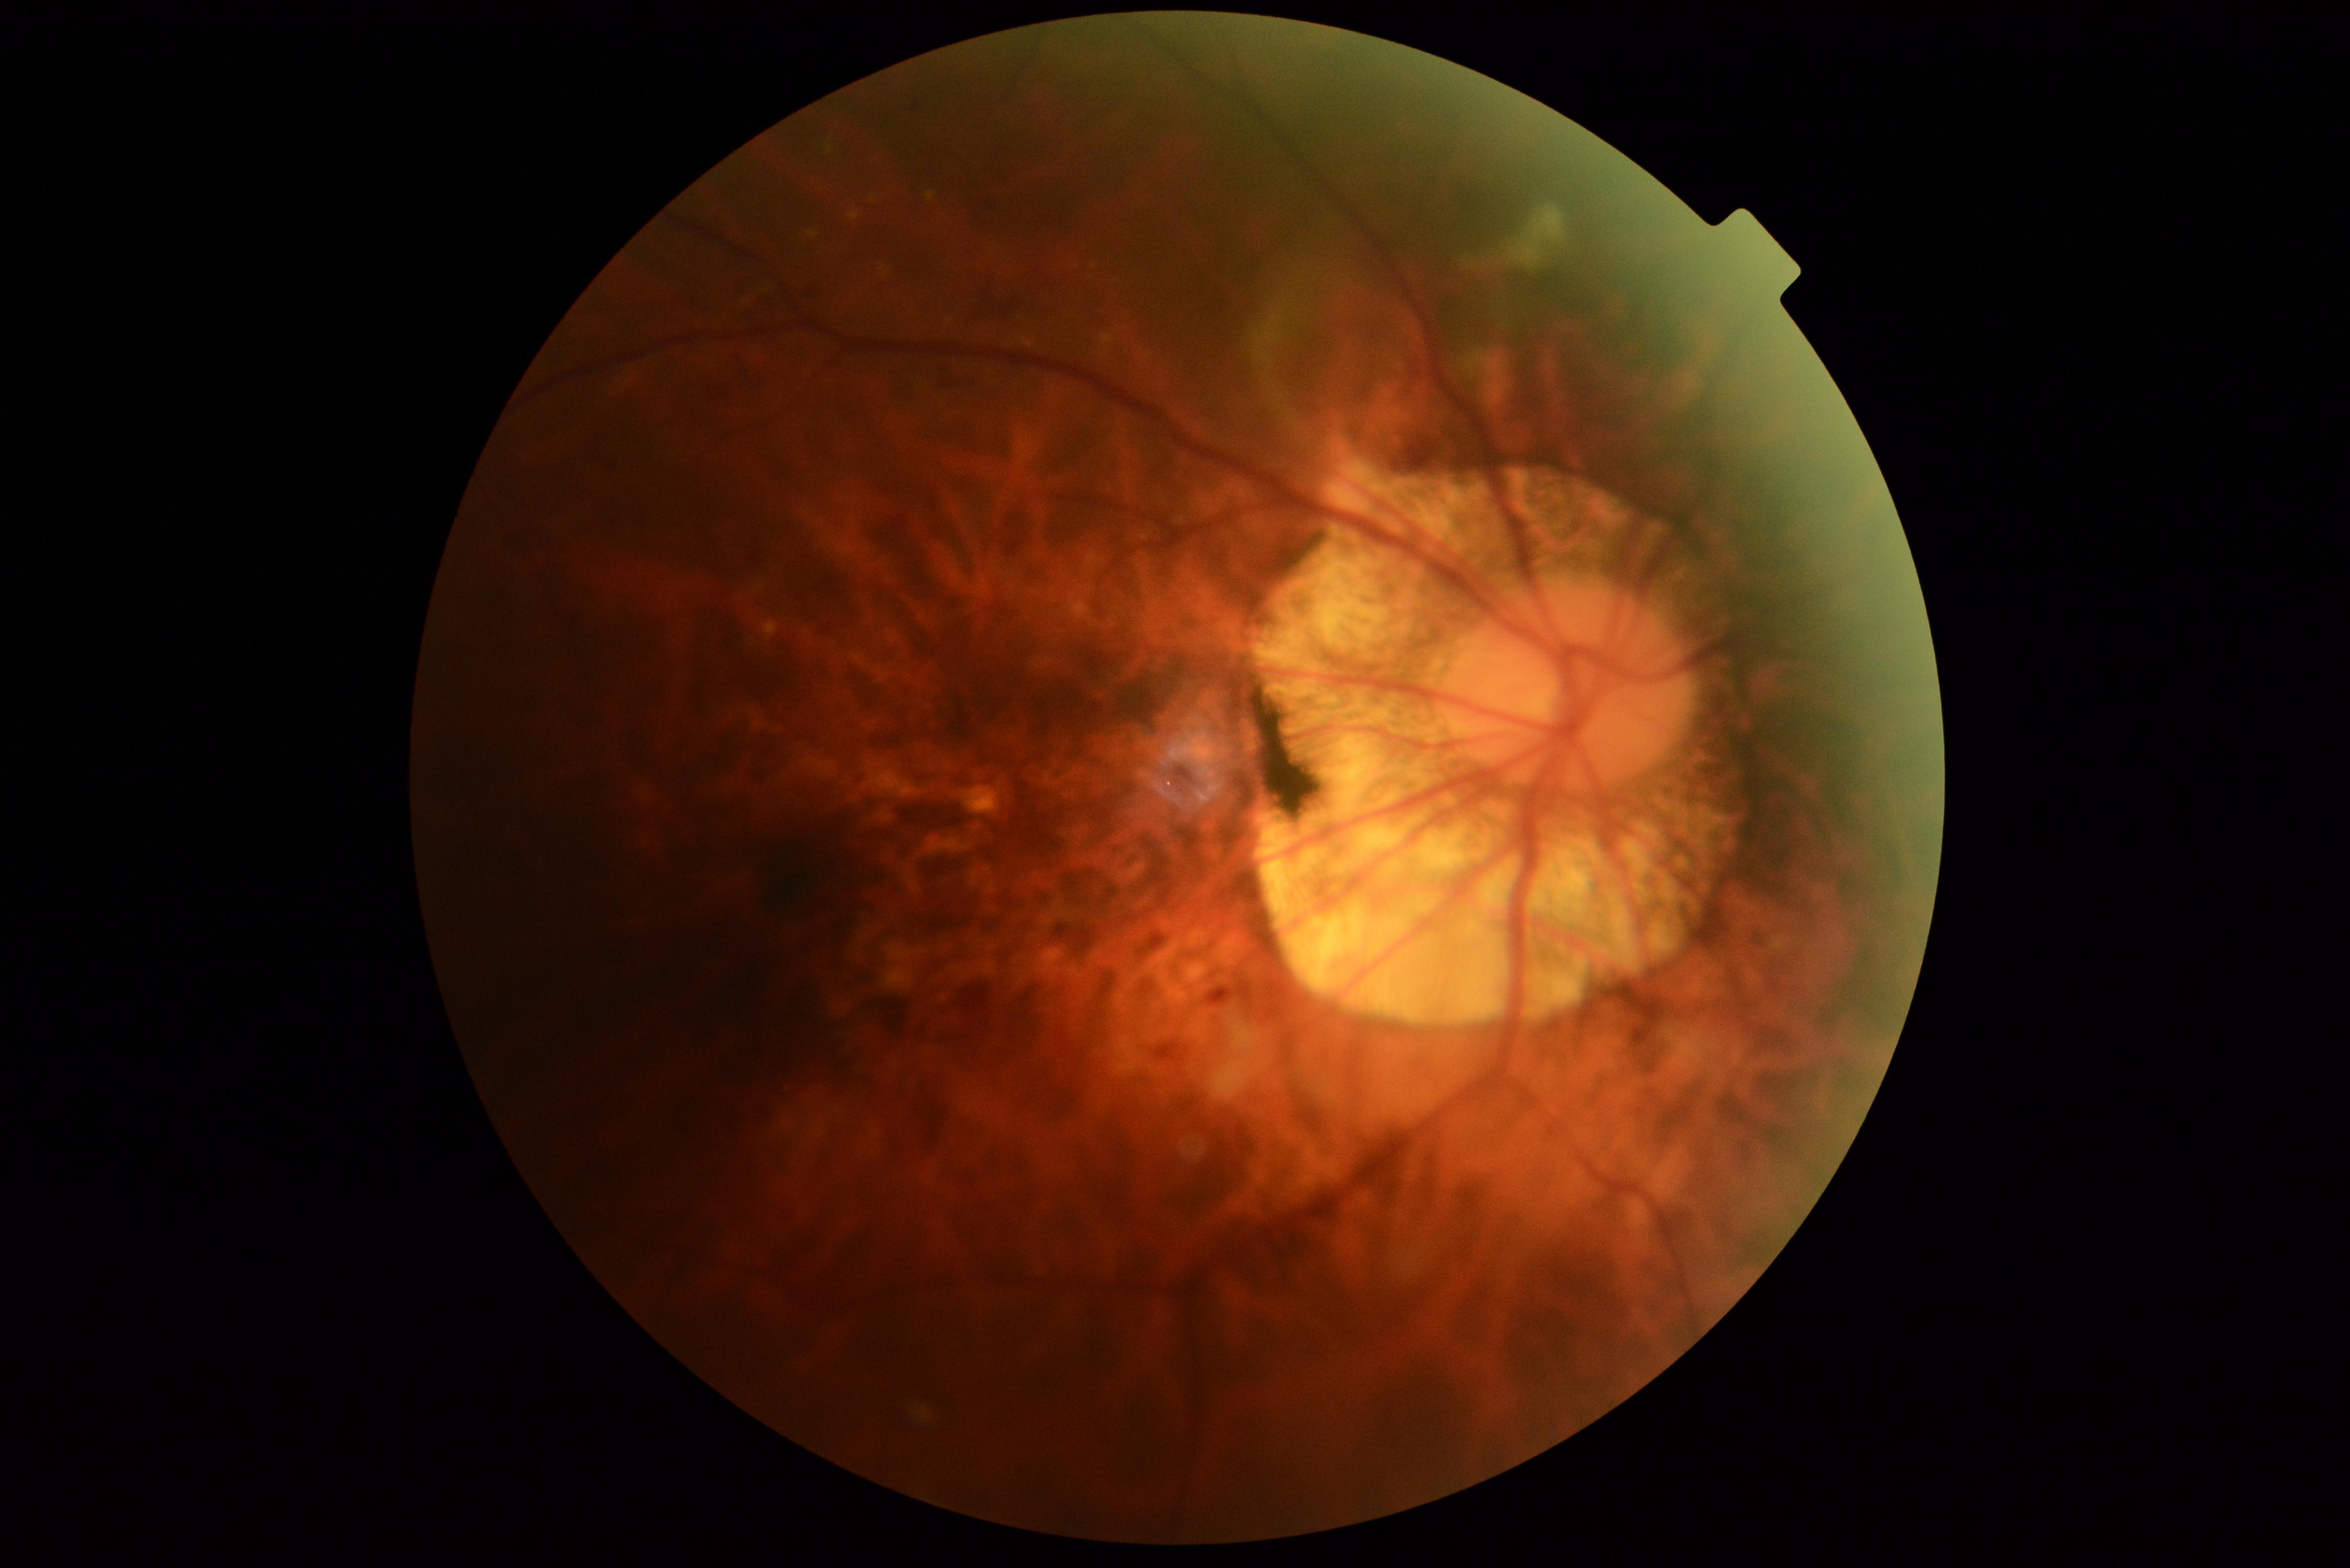
dr_grade: grade 2
dr_category: non-proliferative diabetic retinopathy